FOV: 45 degrees · CFP · modified Davis classification:
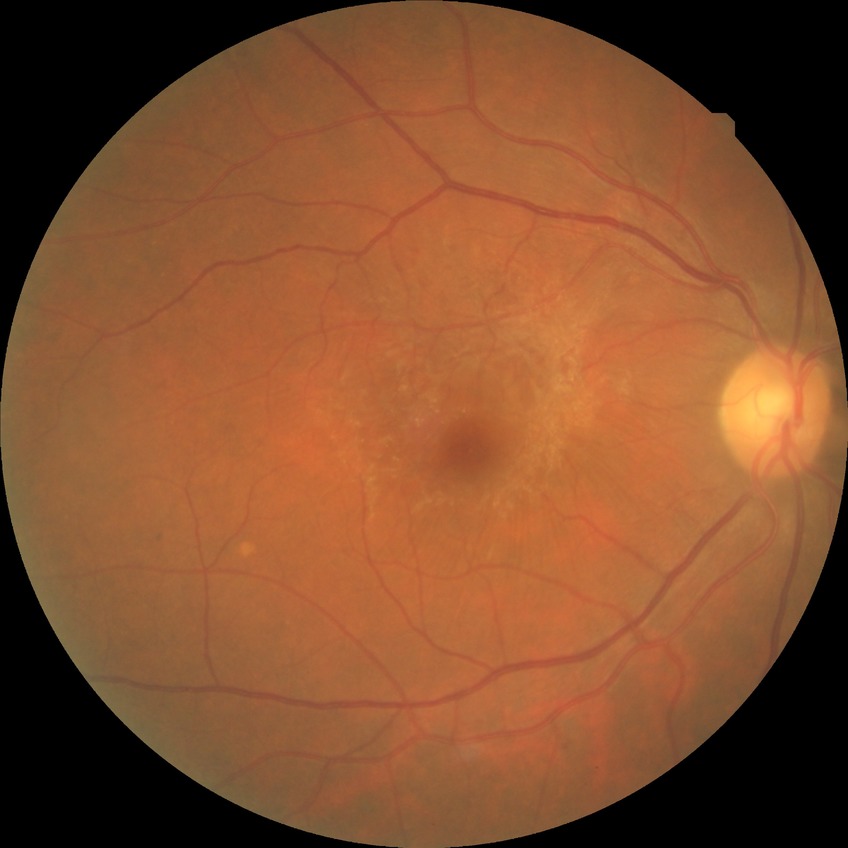 Modified Davis grading: no diabetic retinopathy.